Color fundus photograph. 45 degree fundus photograph. Without pupil dilation — 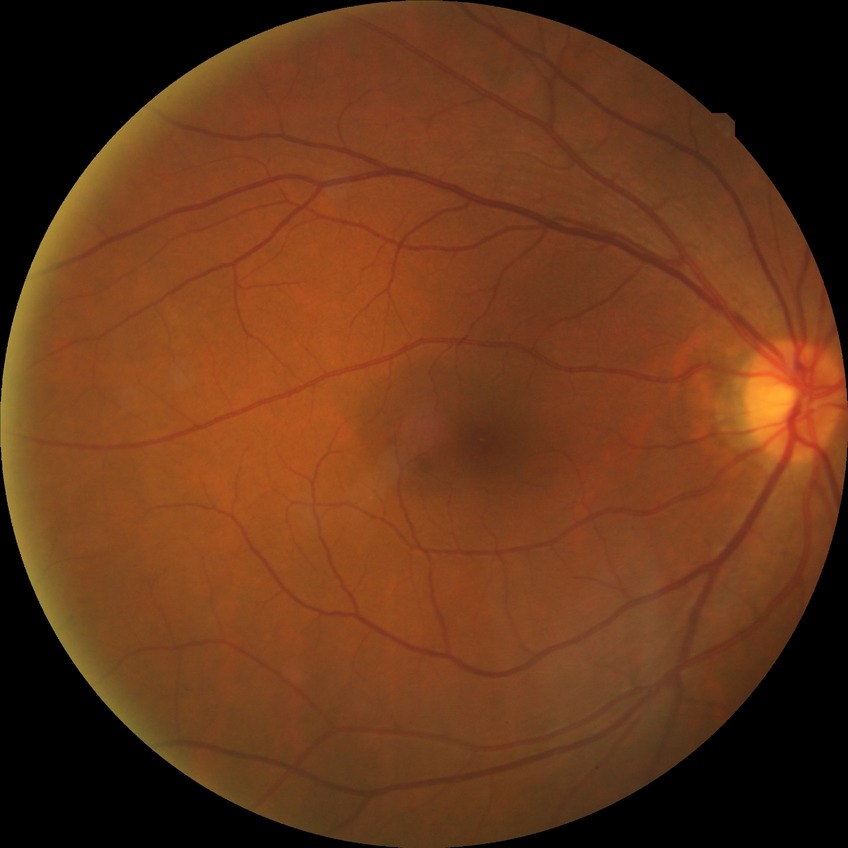

{"davis_grade": "no diabetic retinopathy"}